FOV: 60 degrees · handheld portable fundus camera image · 2212 by 1659 pixels
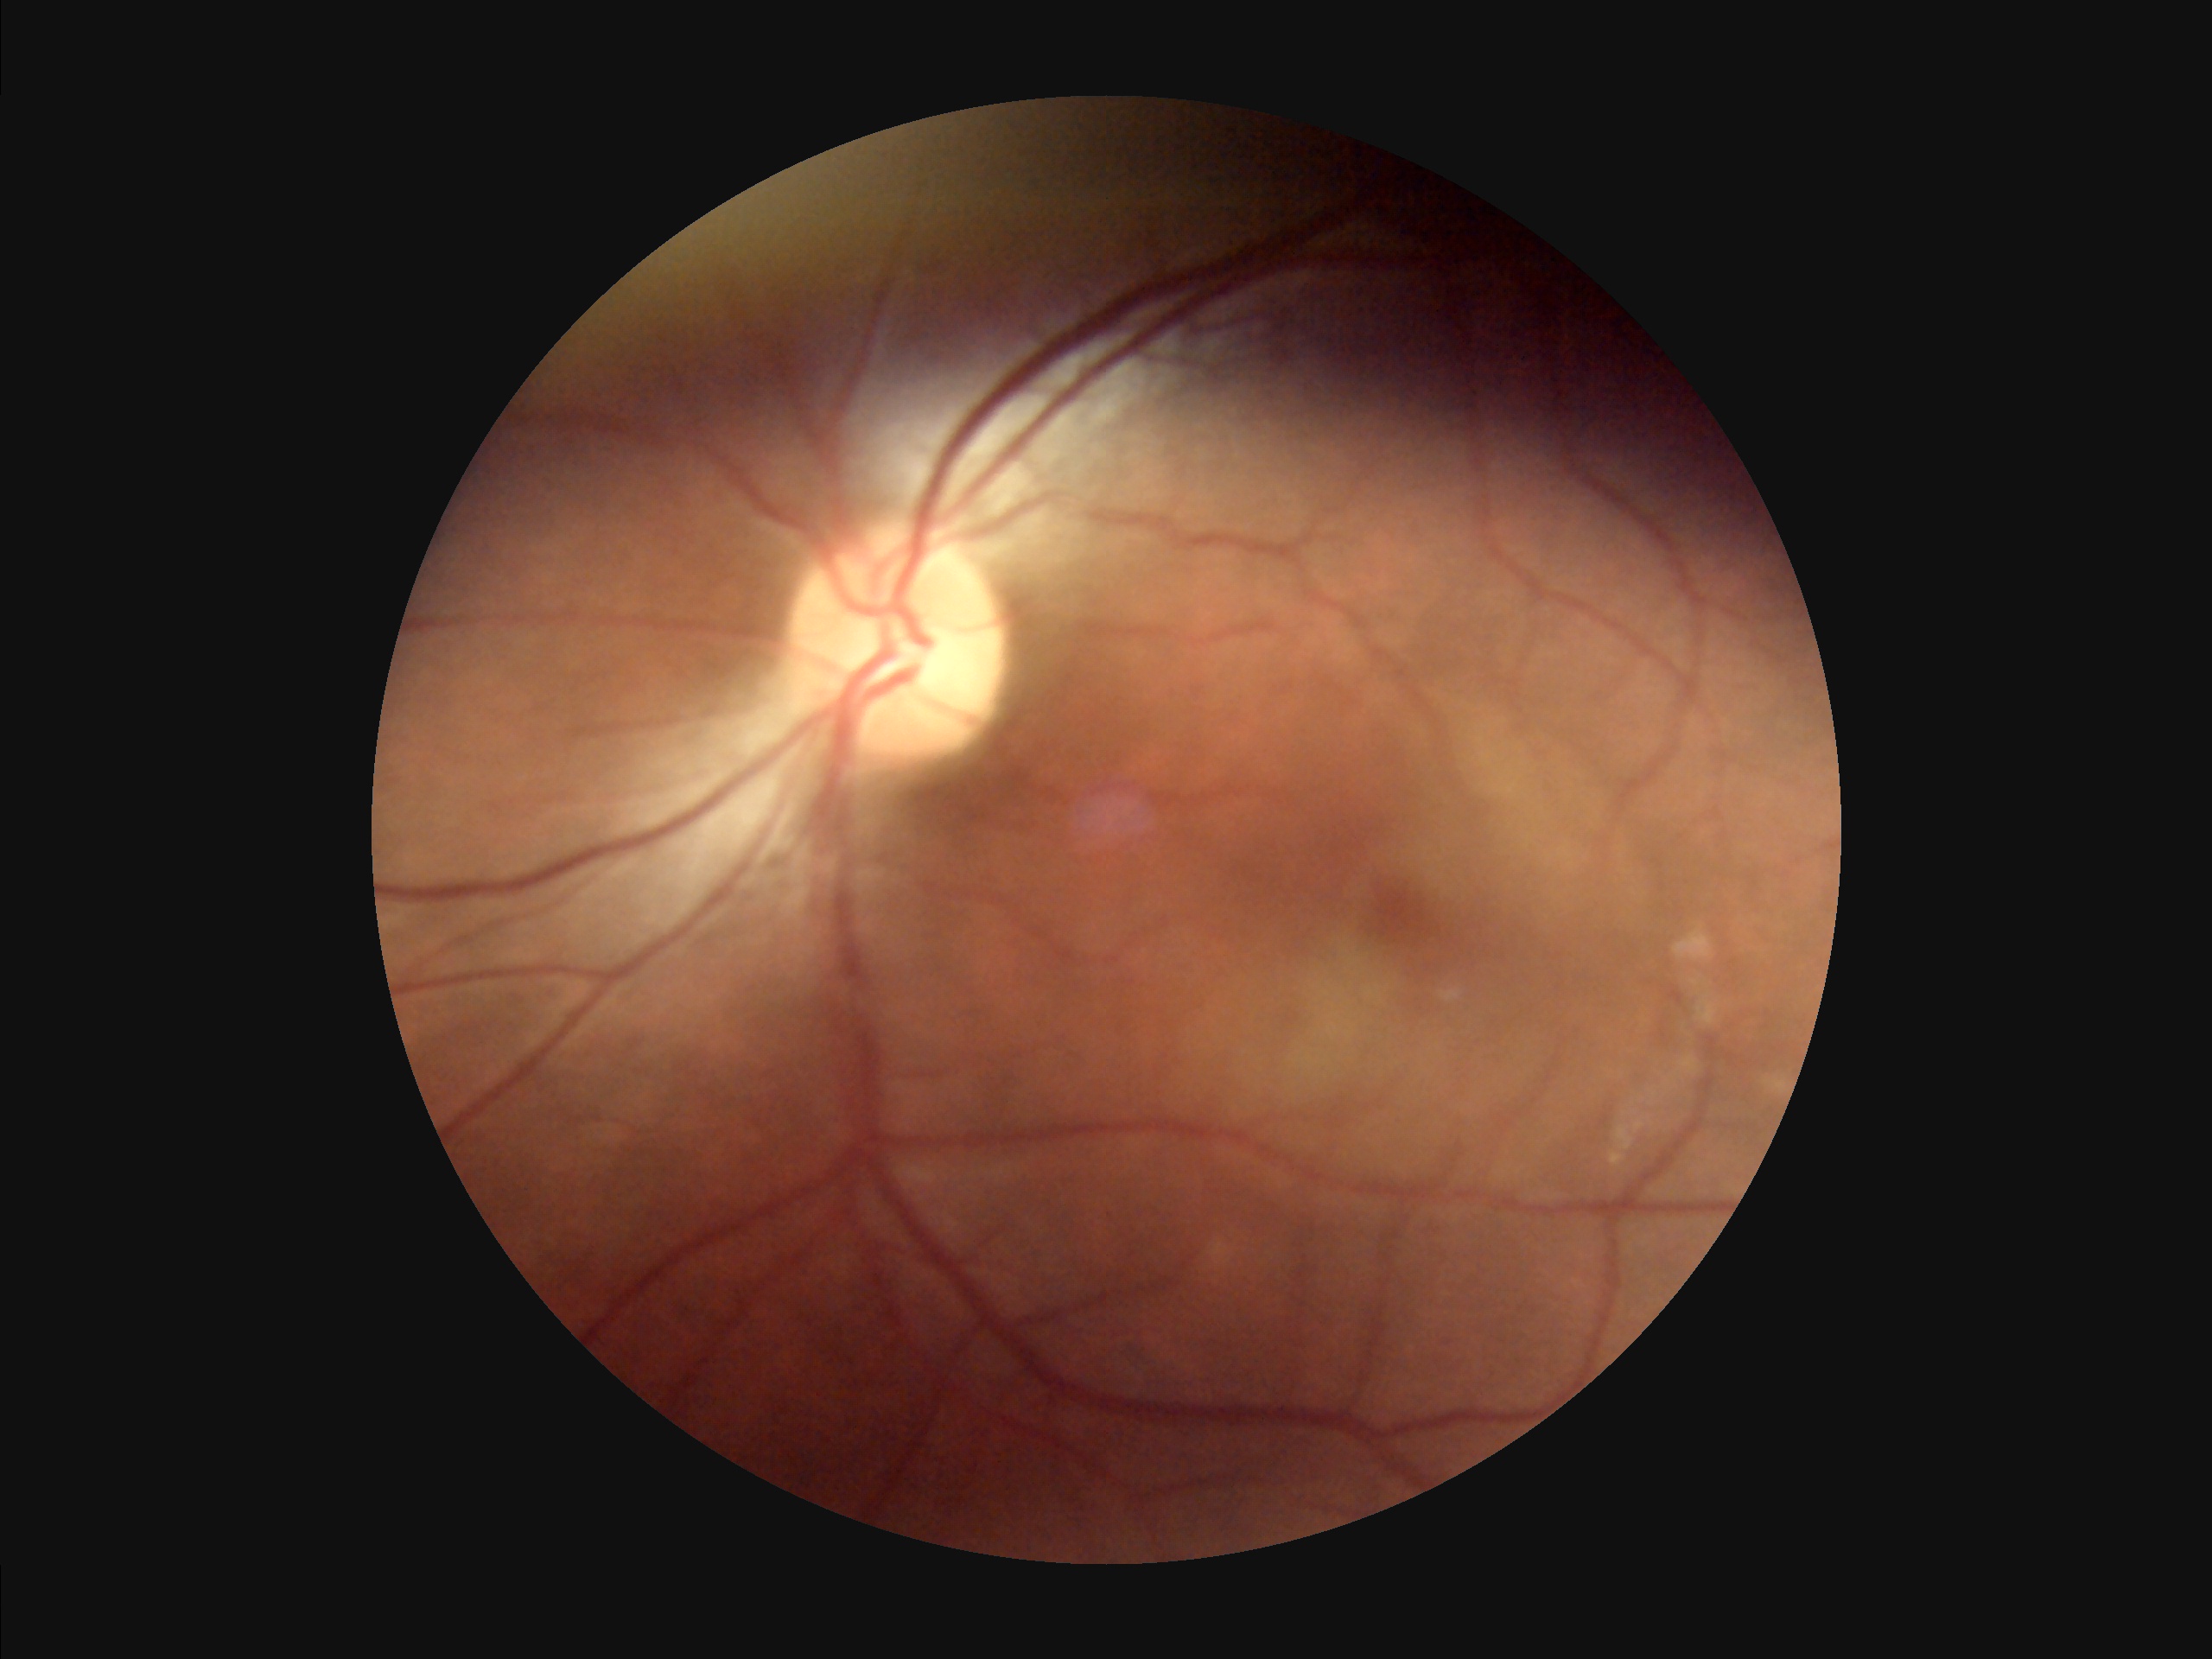 Adequate contrast for distinguishing structures. There is over- or under-exposure or a color cast. Overall quality is good and the image is gradable. No noticeable blur.